2352 x 1568 pixels, FOV: 45 degrees
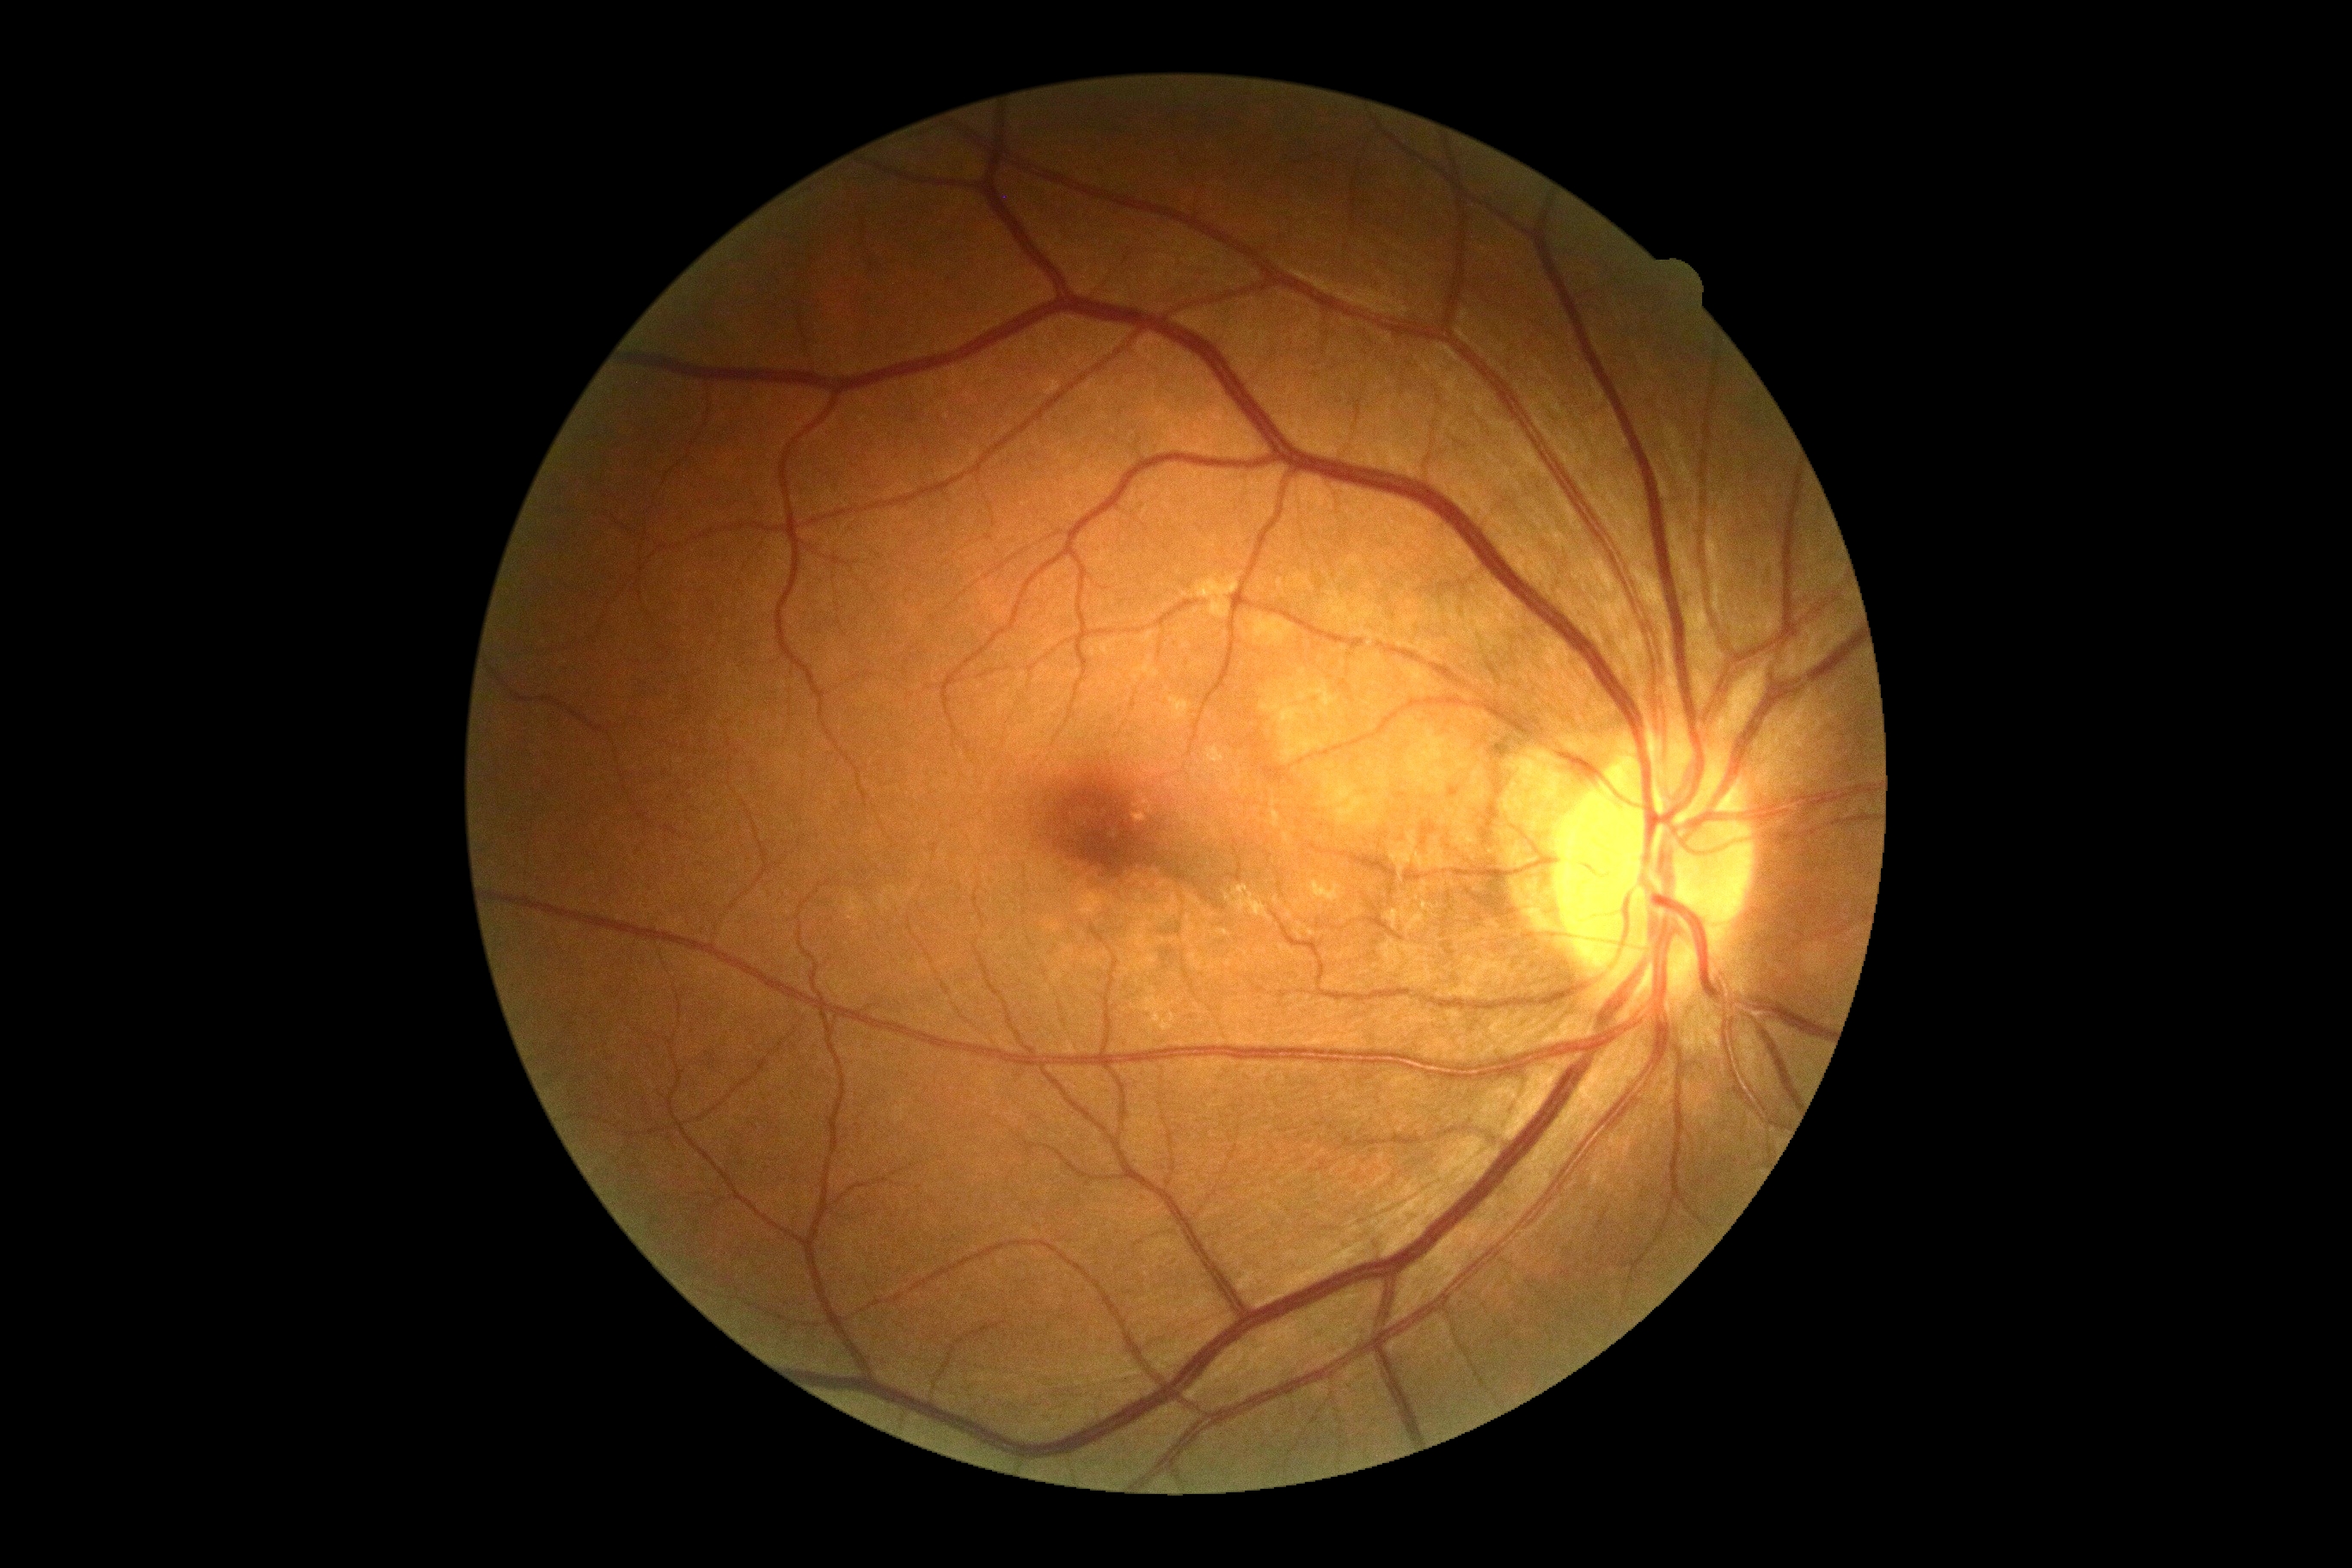

No diabetic retinal disease findings. Diabetic retinopathy grade: no apparent retinopathy (0).